Captured on a Remidio smartphone fundus camera · fundus photo · 1659 x 2212 pixels.
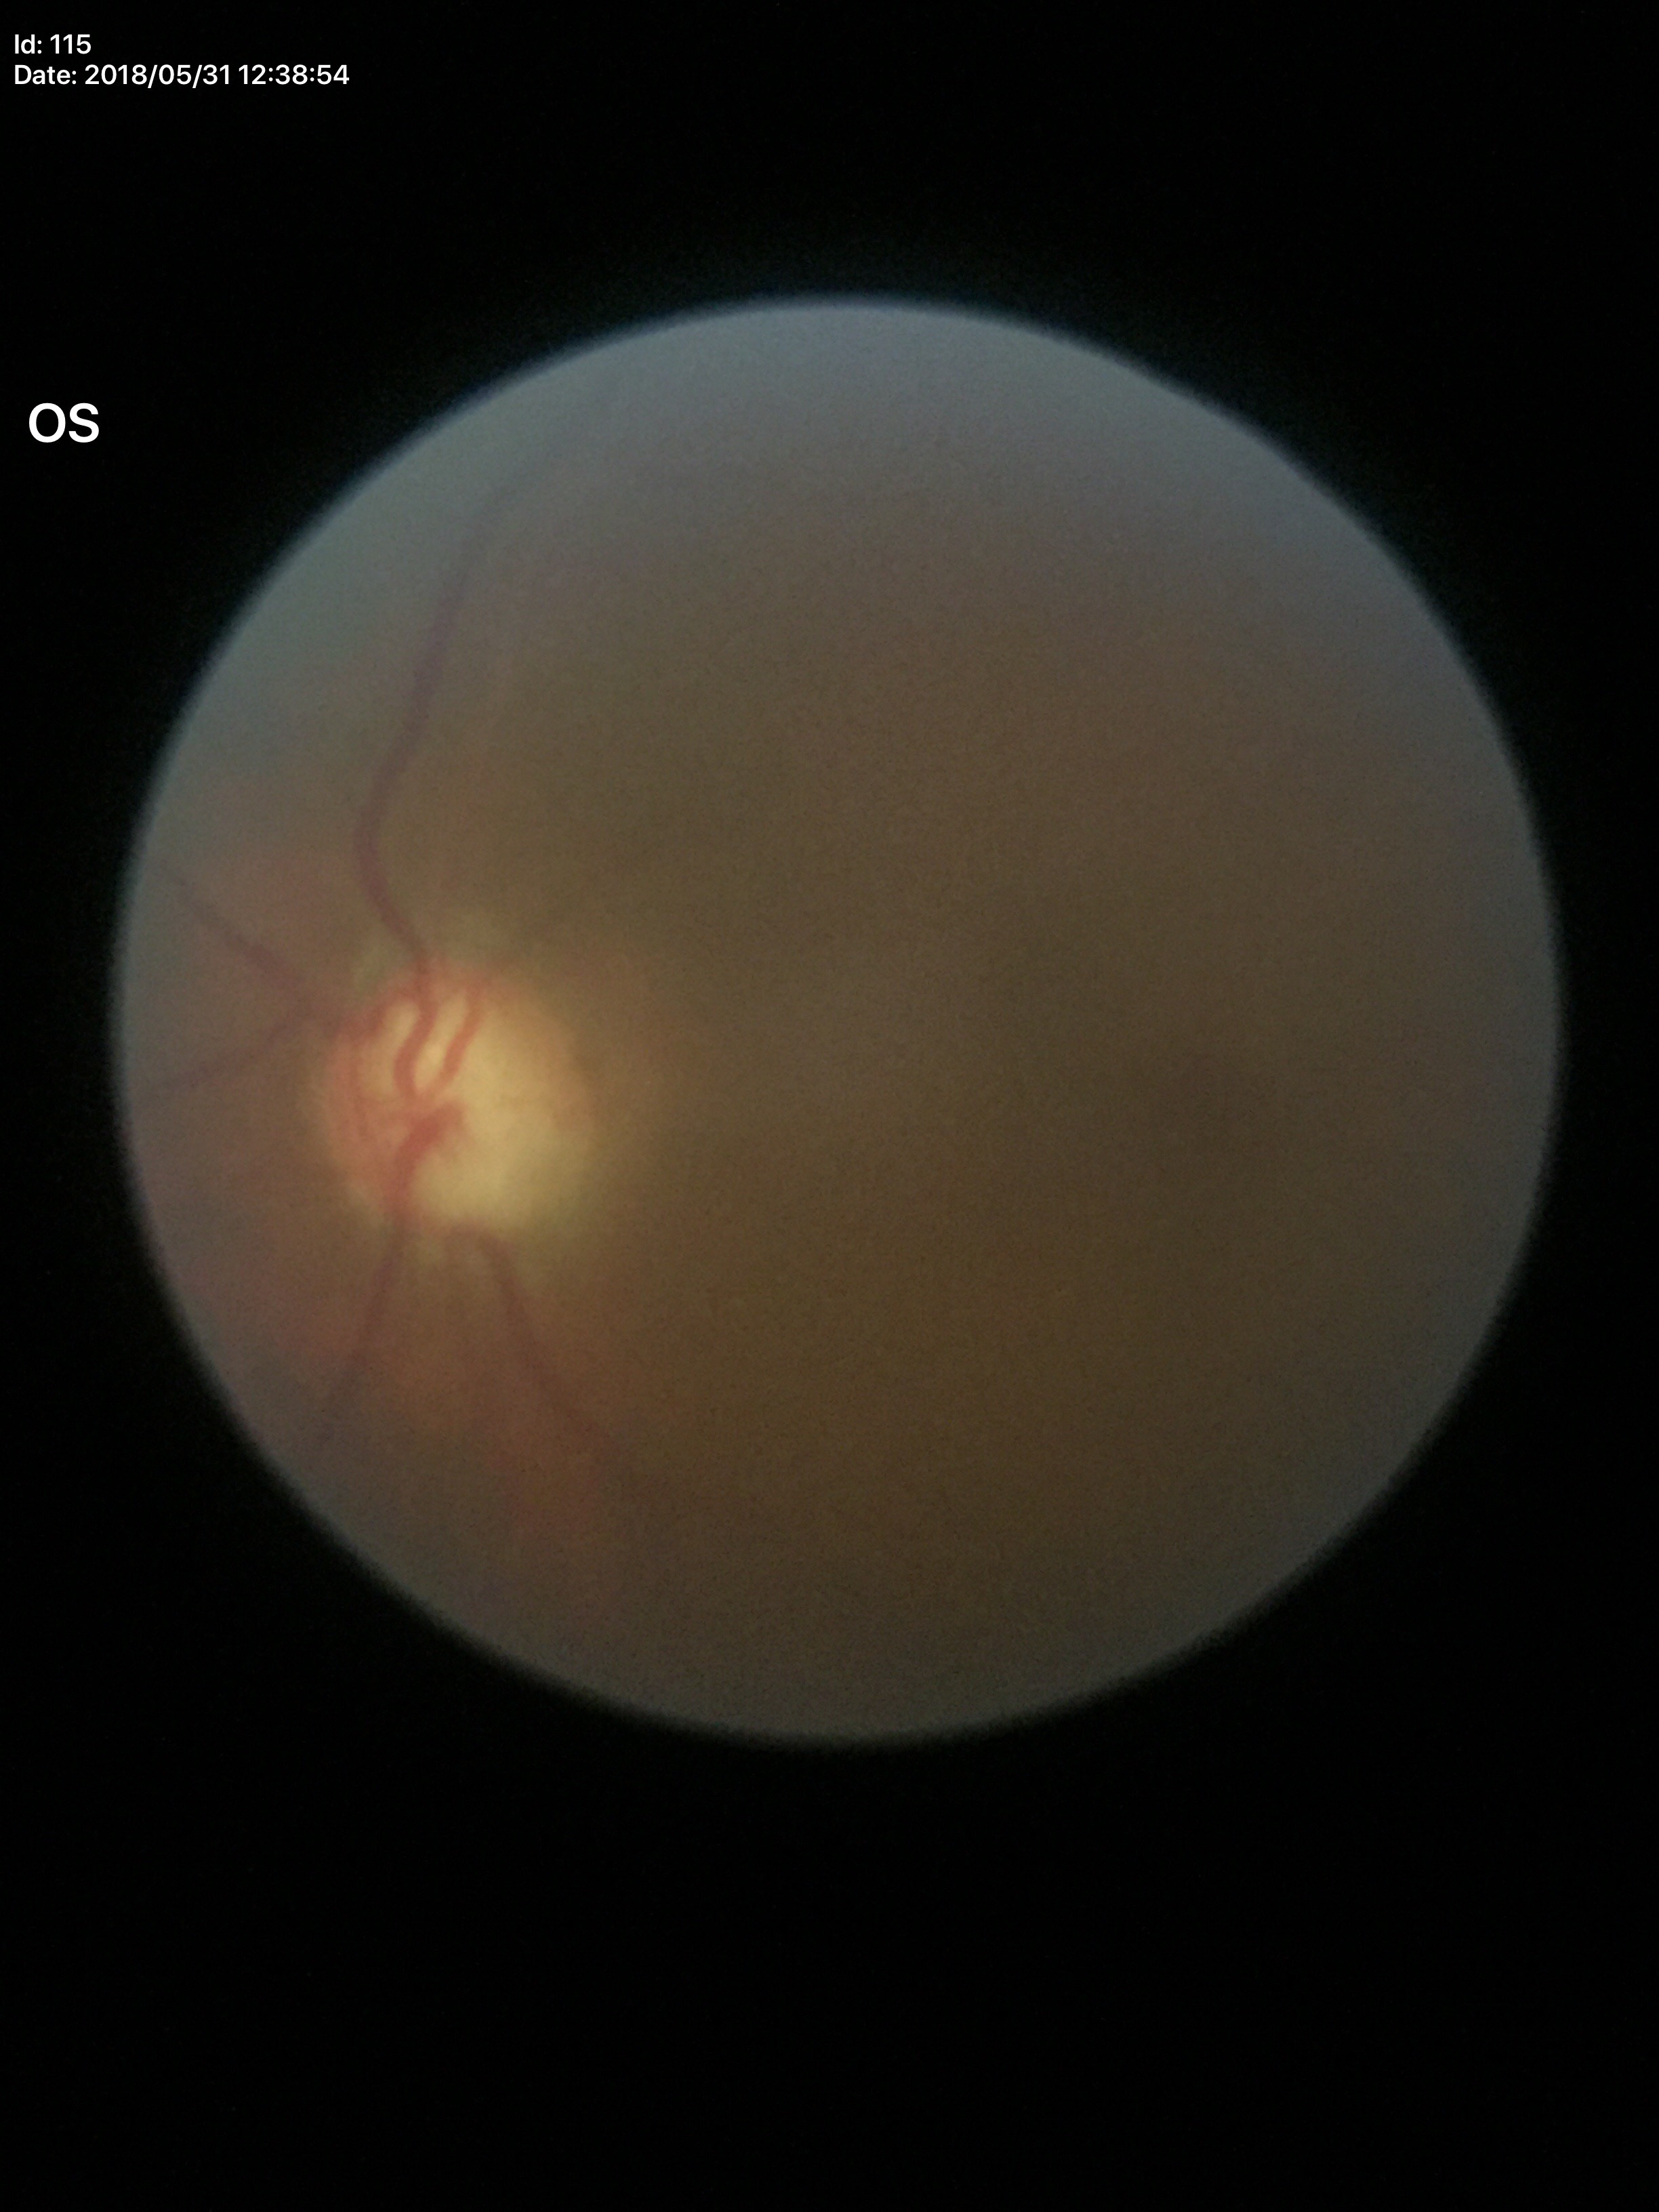 Glaucoma impression = suspect | vertical cup-to-disc ratio = 0.85.